30-degree field of view: 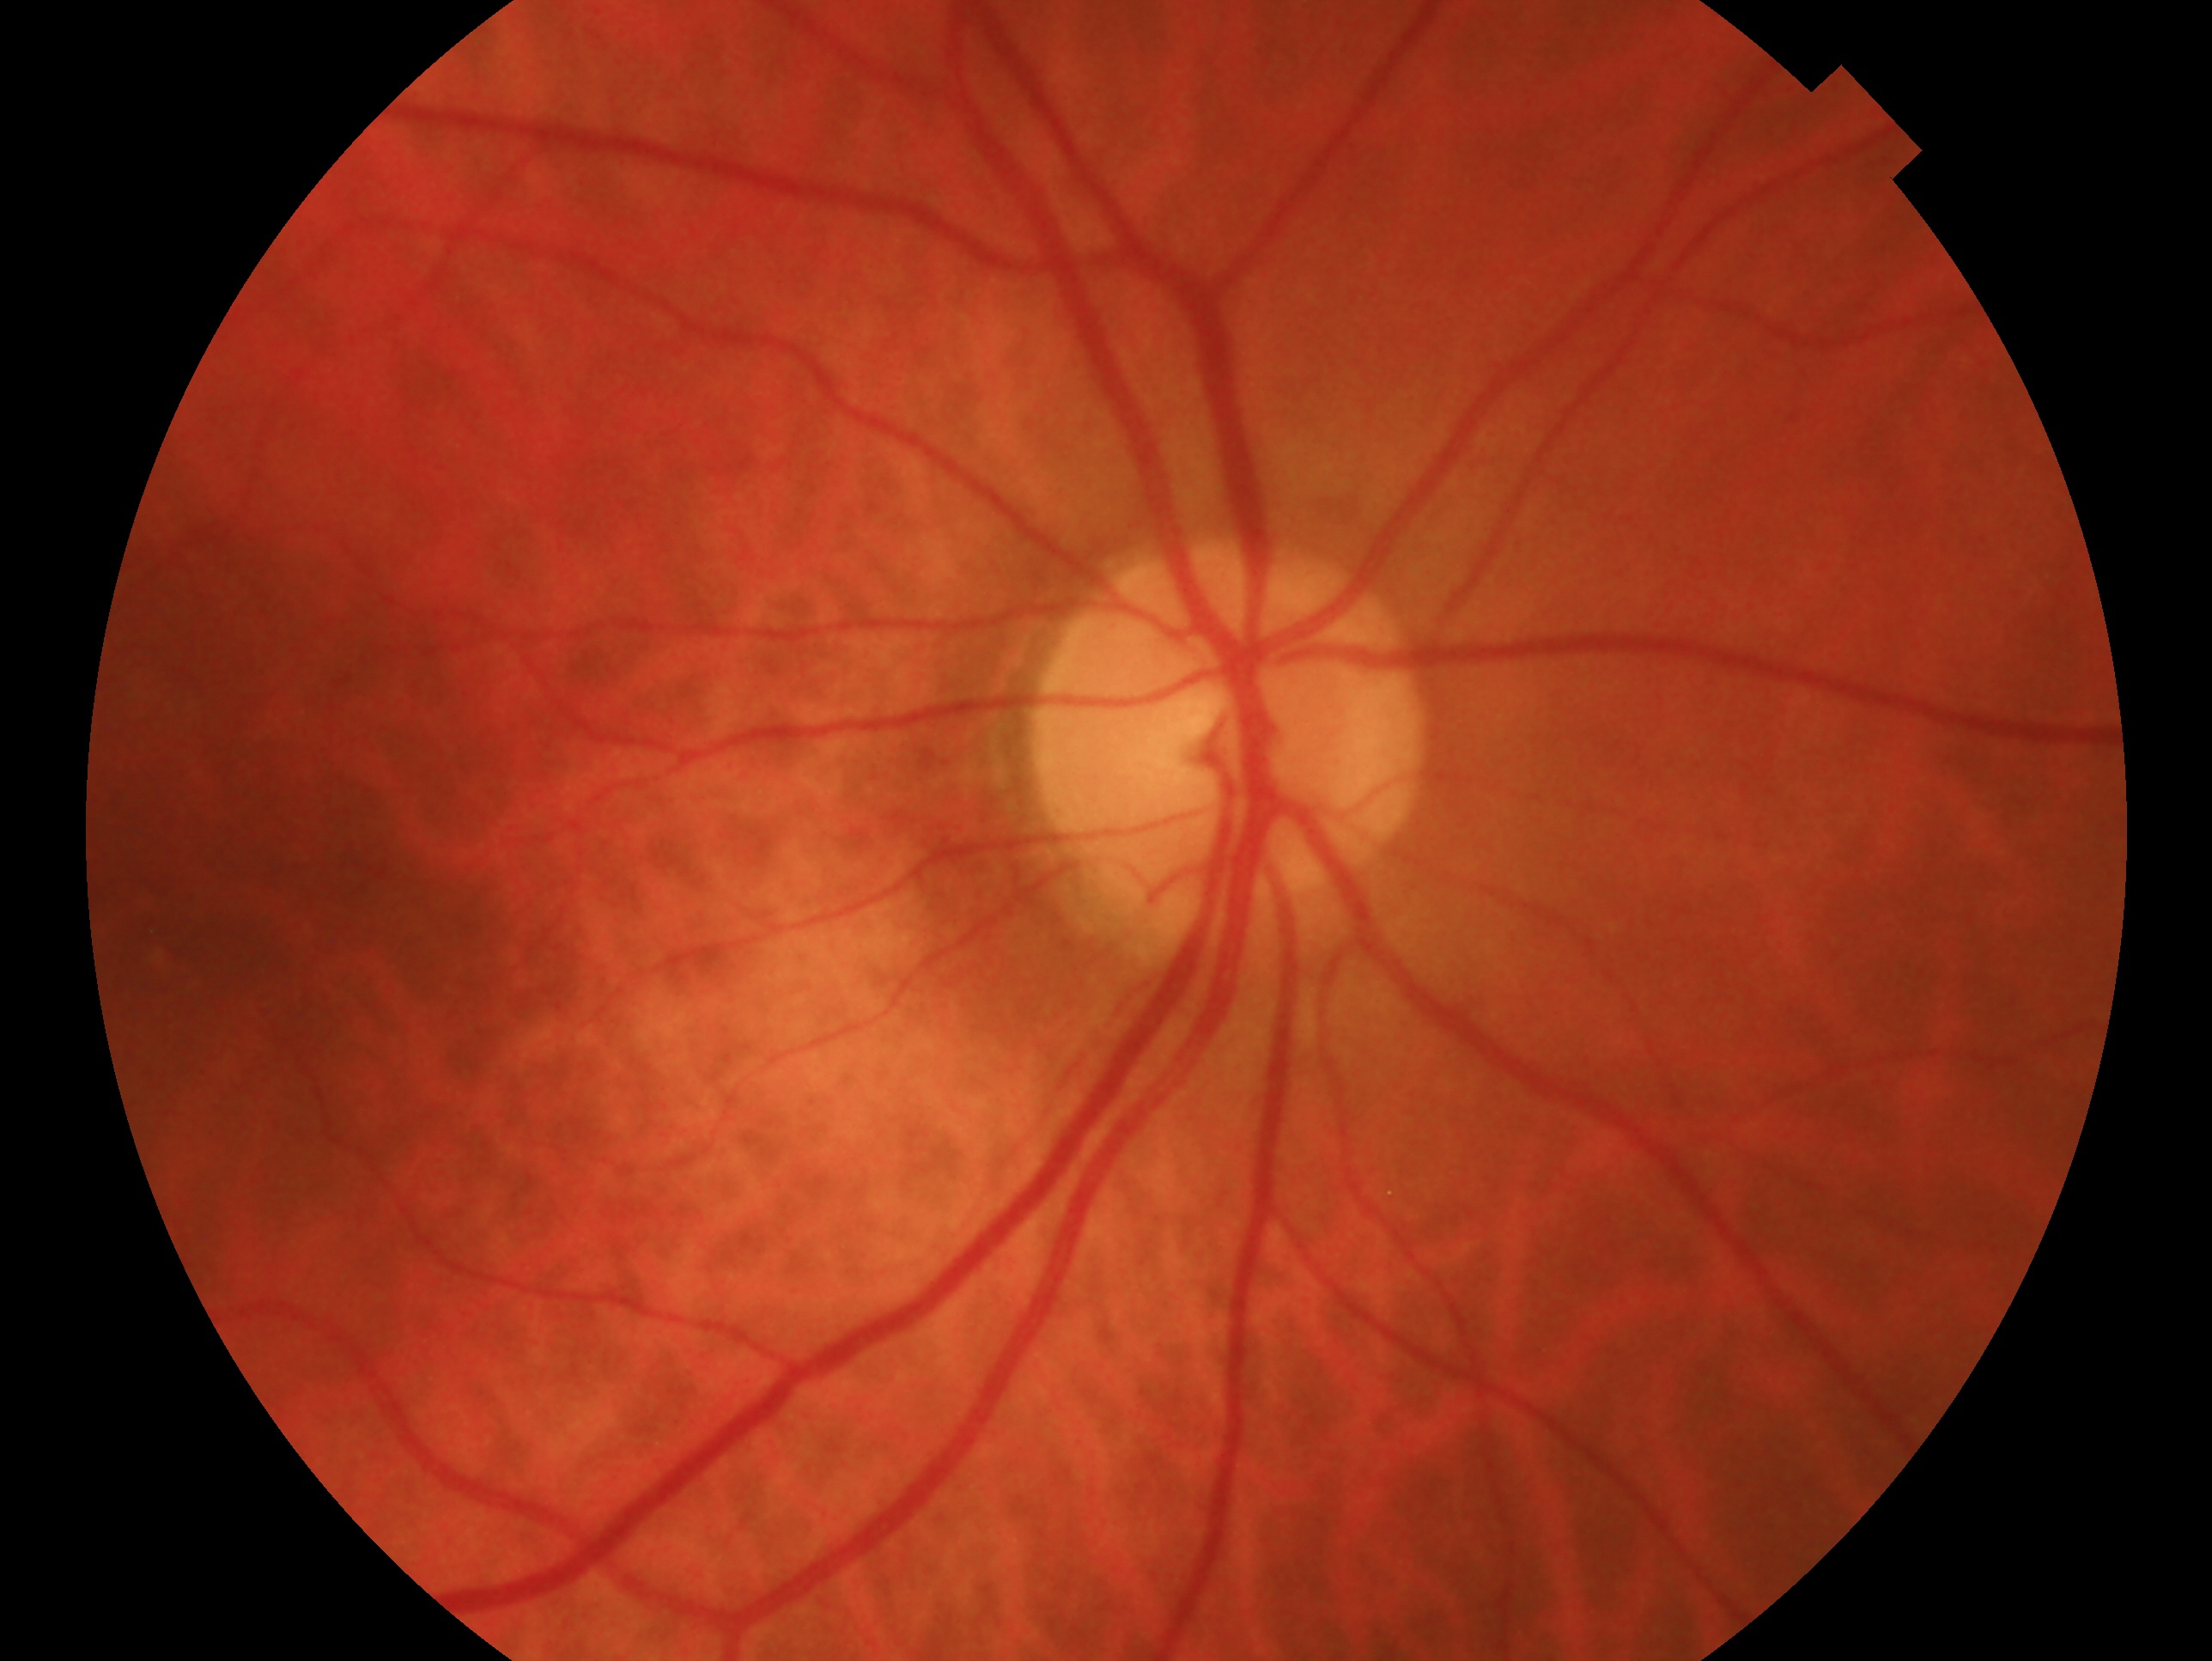 eye: OD | clinical classification: no signs of glaucoma.